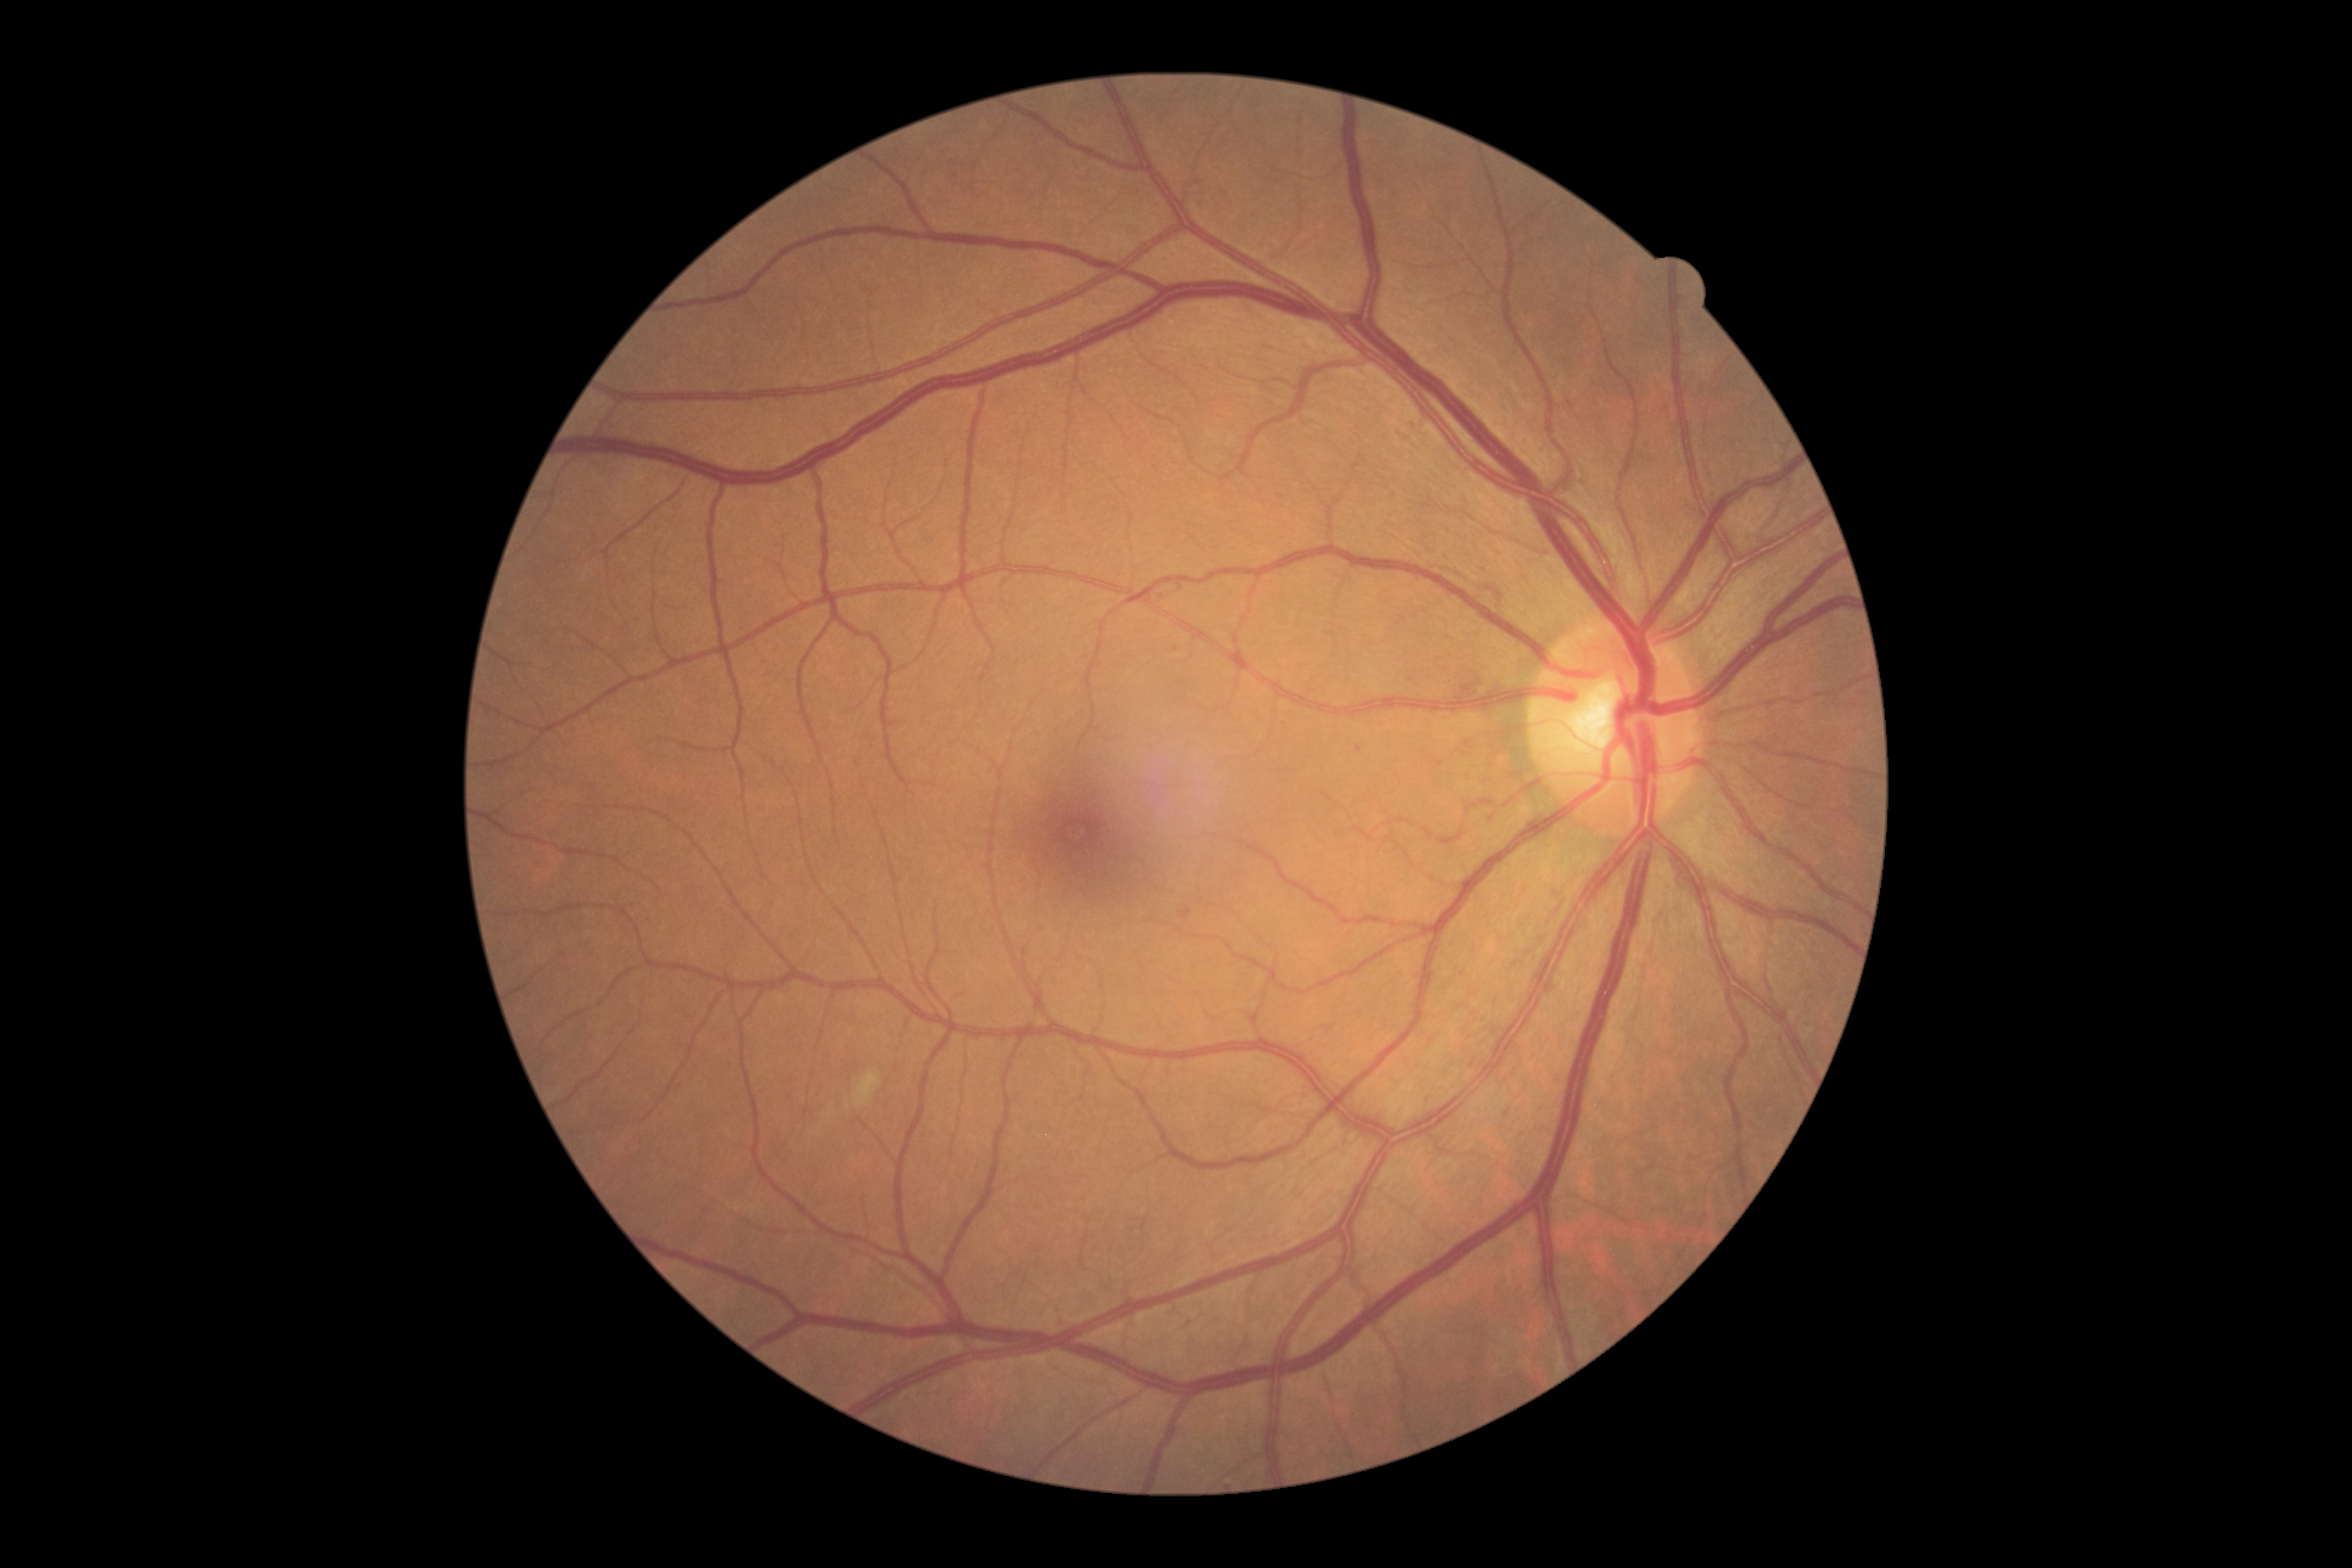
DR severity: 2/4.